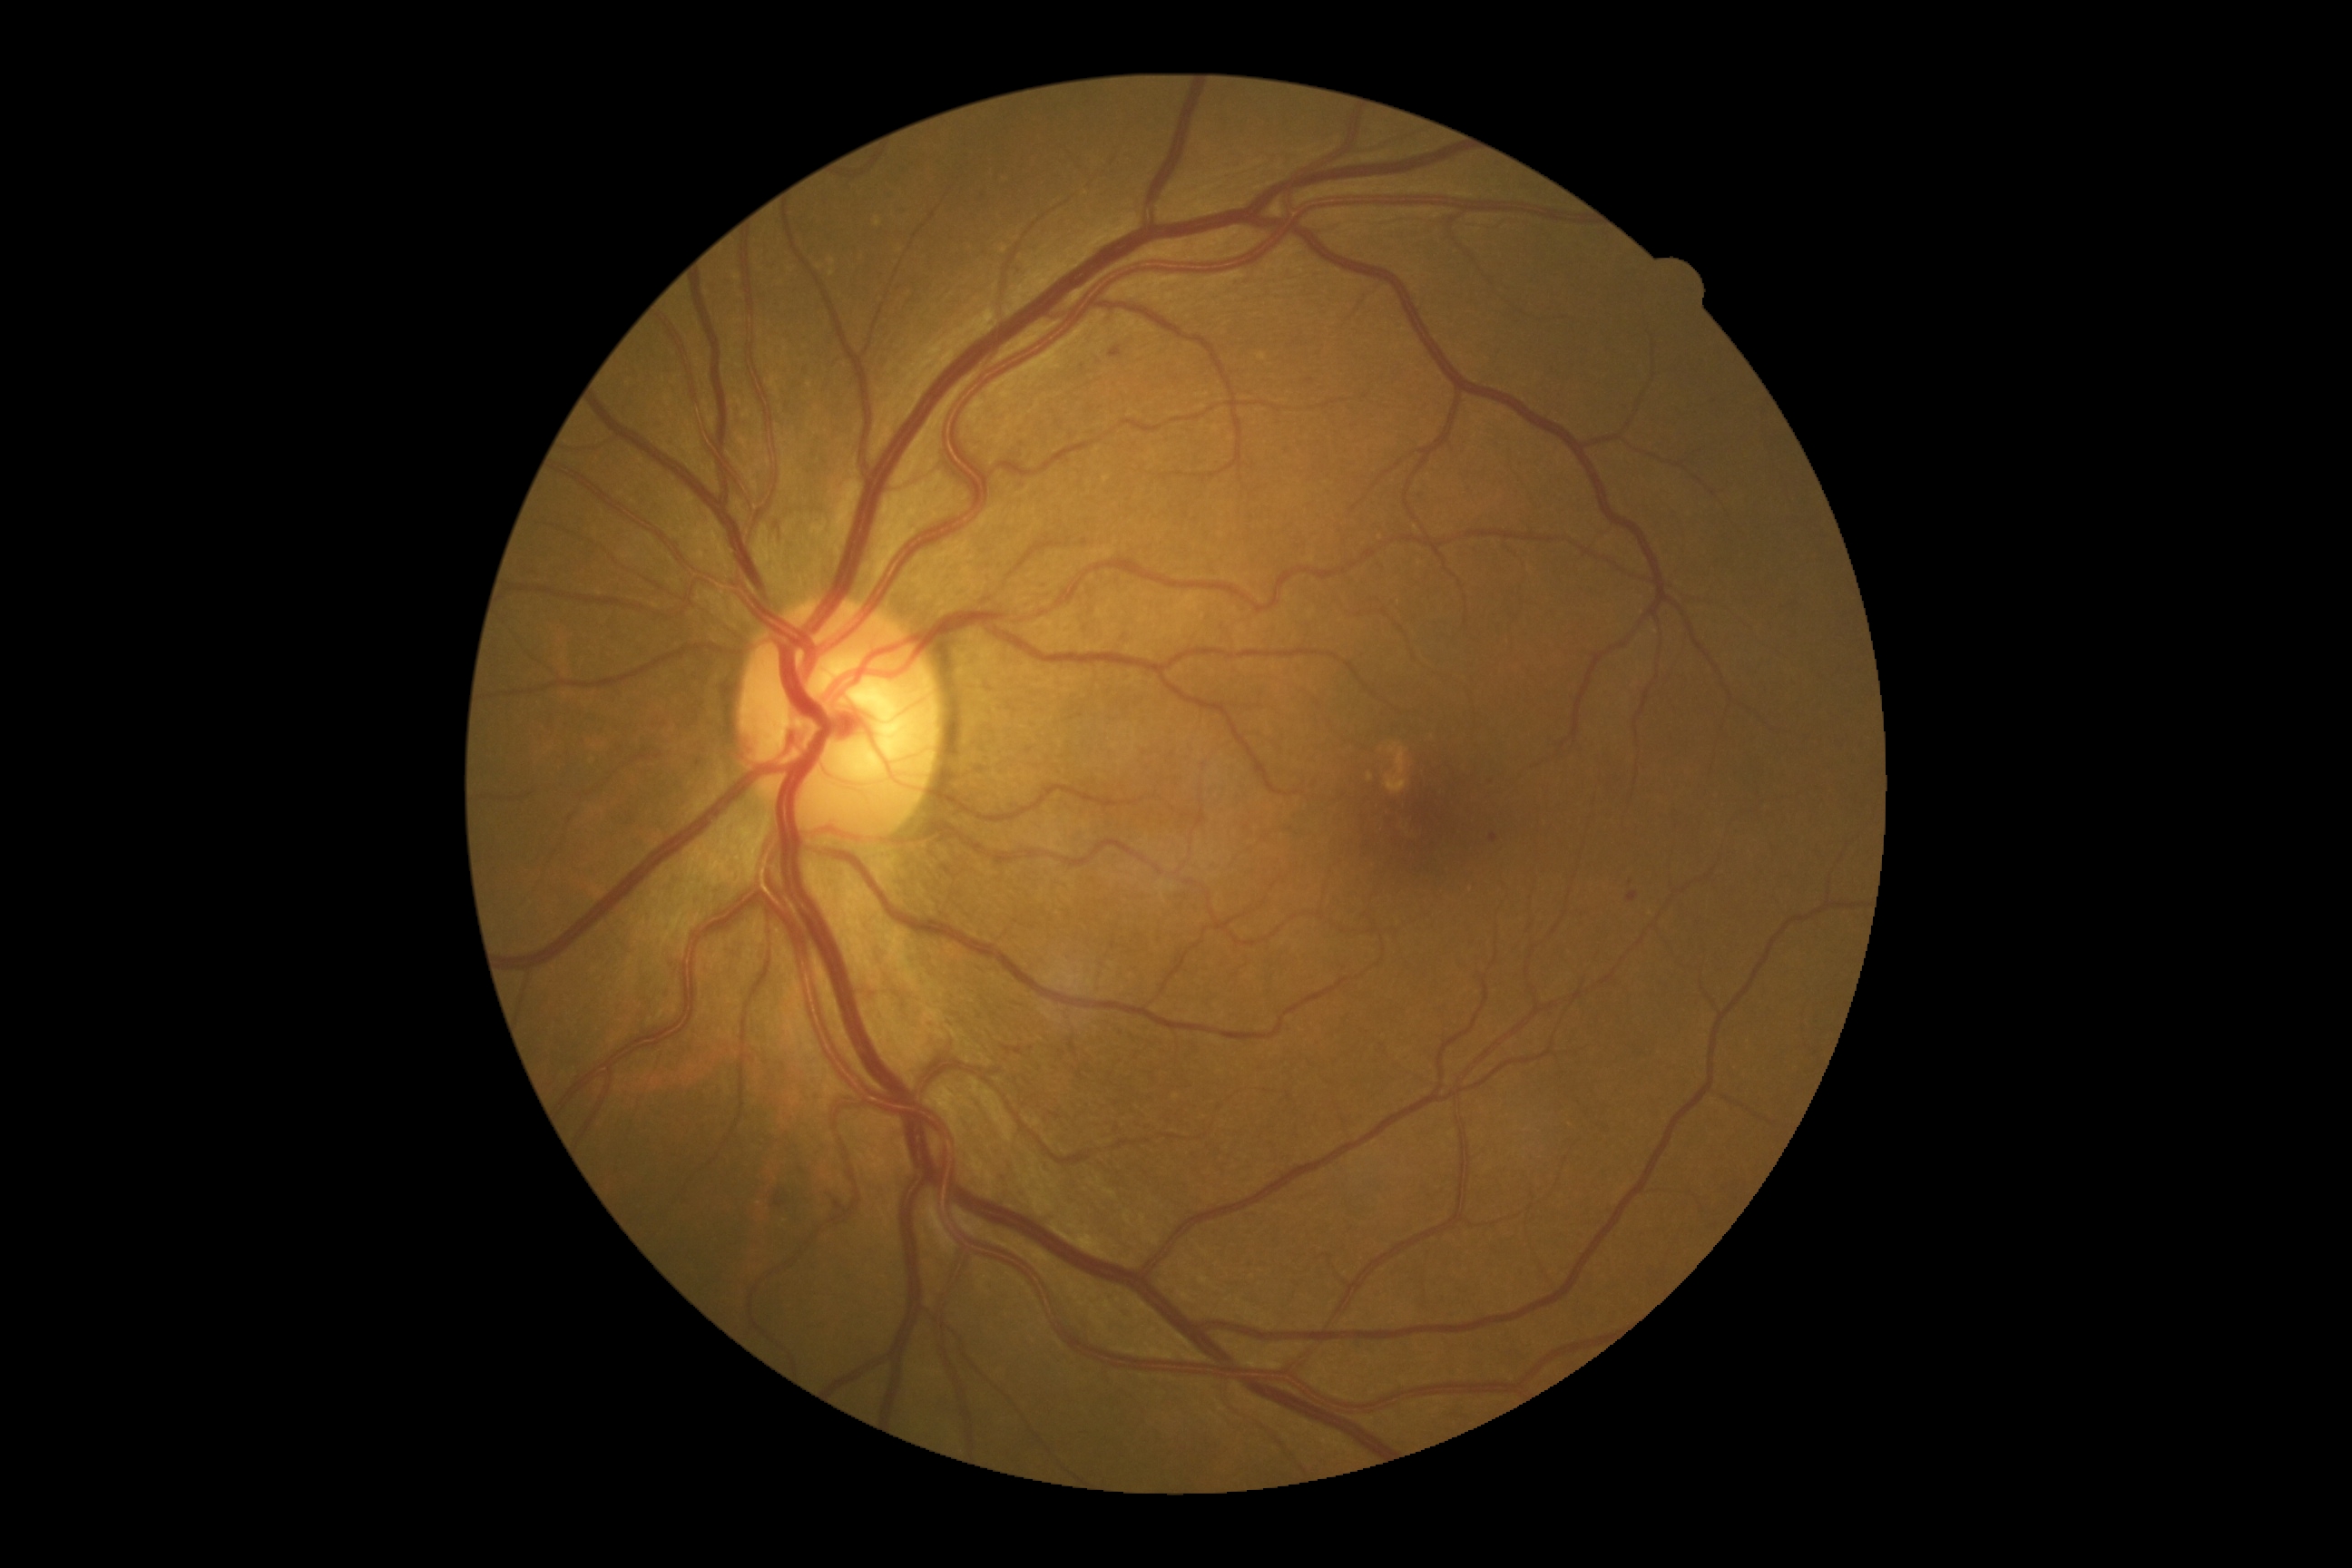

DR grade is 2 (moderate NPDR). Disease class: non-proliferative diabetic retinopathy.